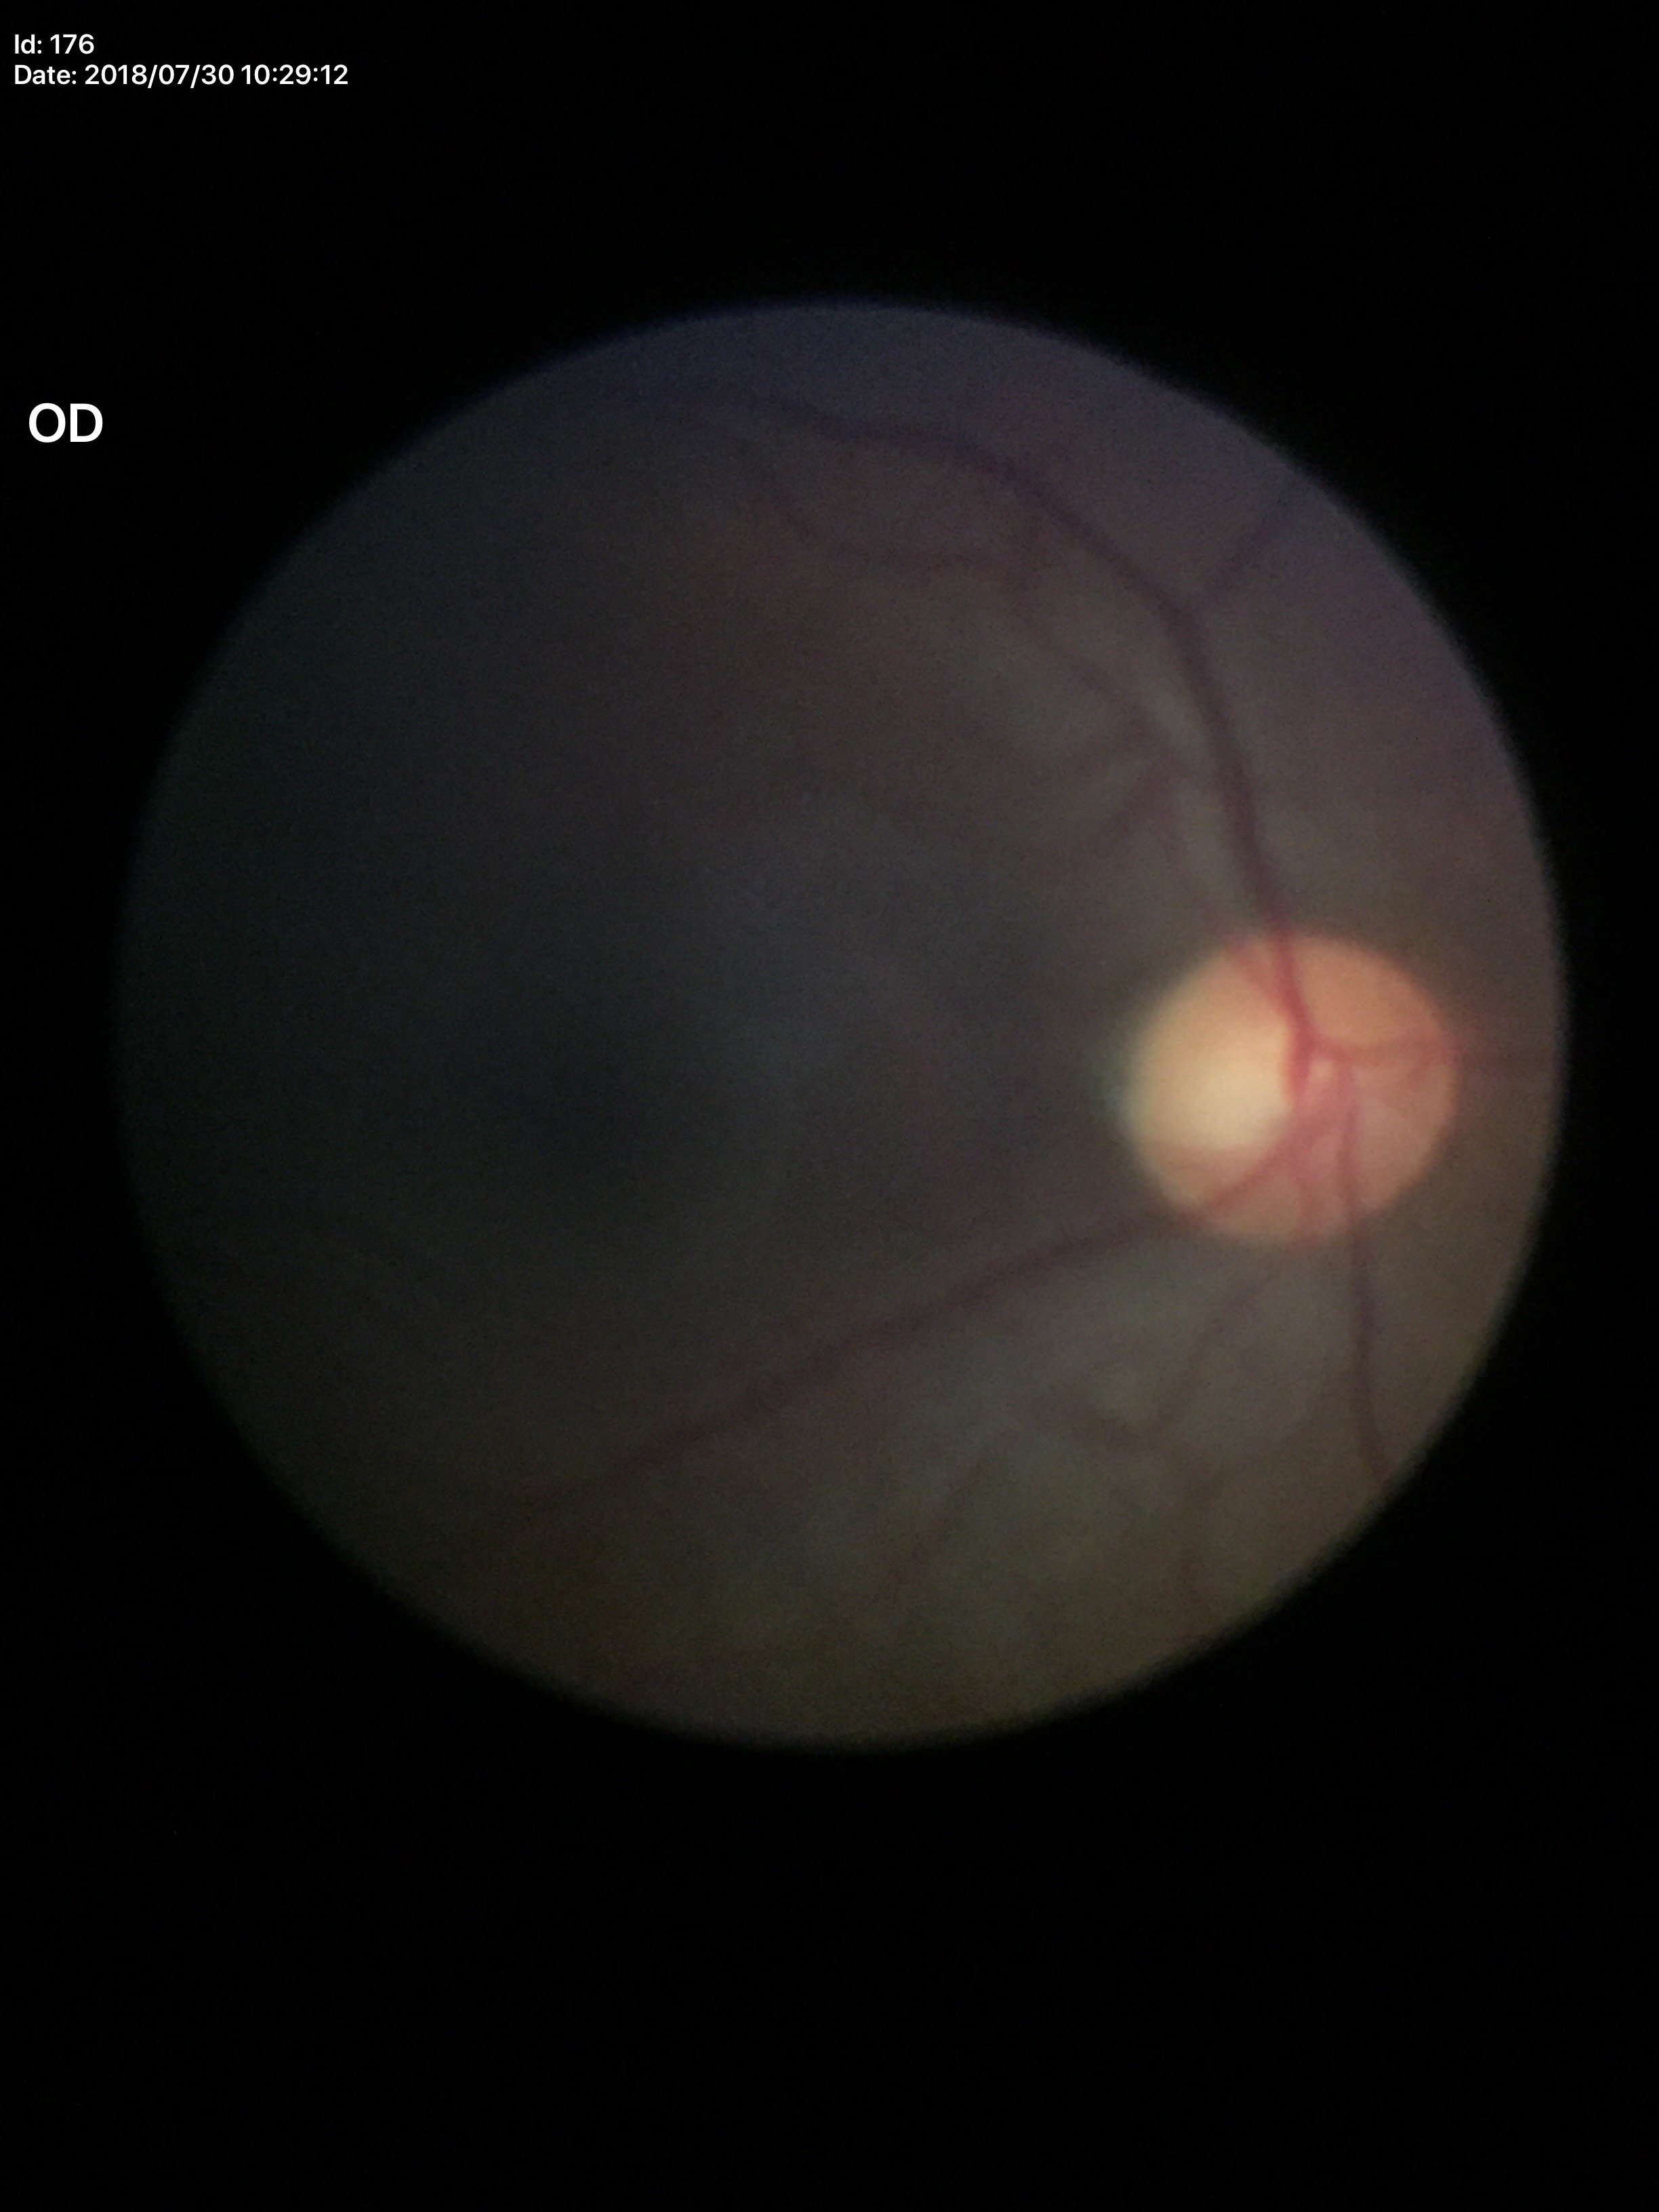
  acdr: 0.23
  glaucoma_decision: not suspect
  vcdr: 0.48